Color fundus image; without pupil dilation — 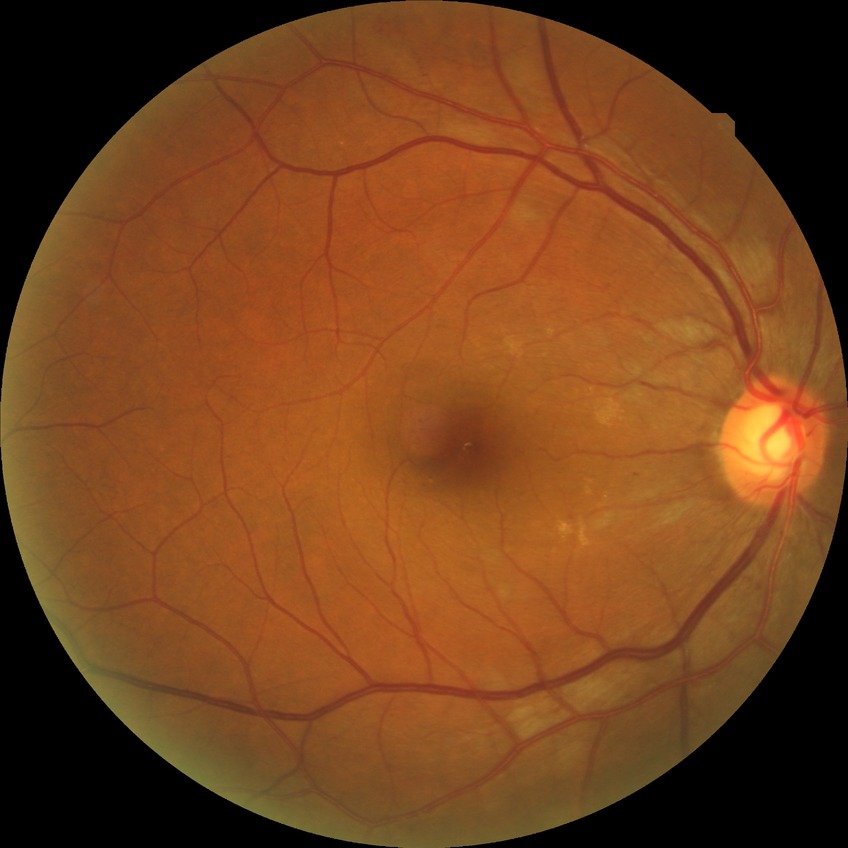 Diabetic retinopathy (DR) is simple diabetic retinopathy (SDR).